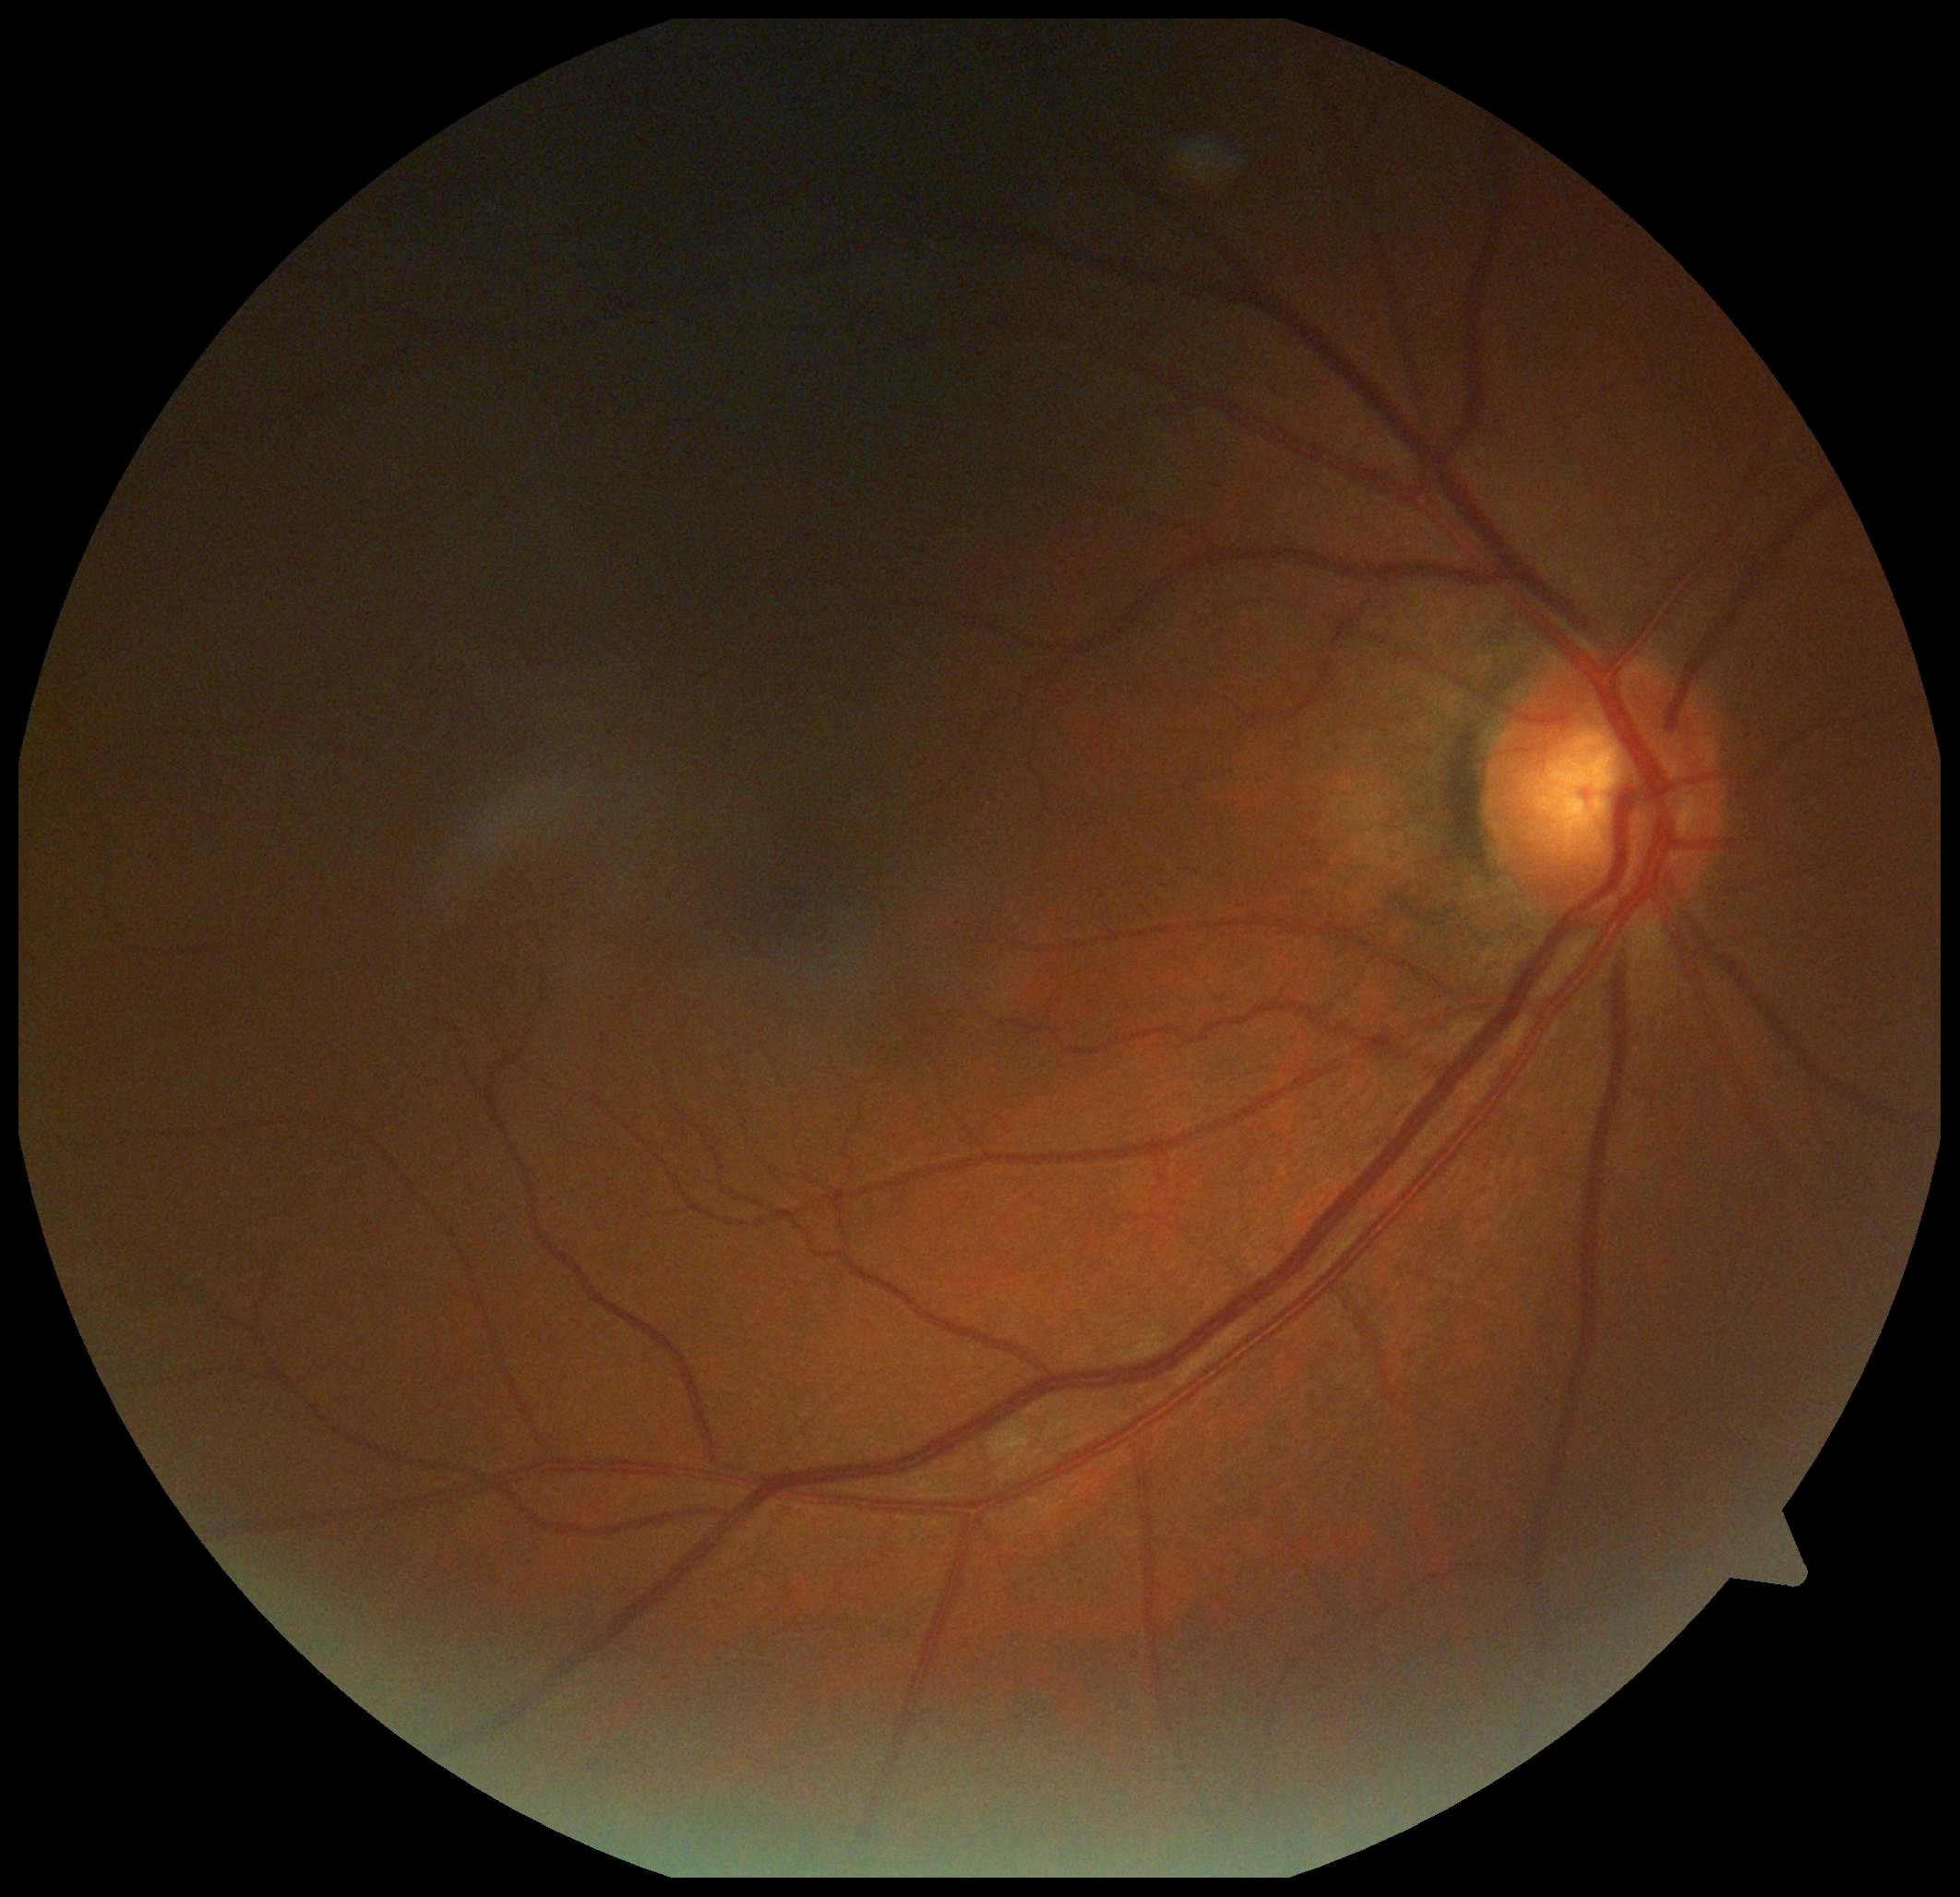
DR: 2.